Davis DR grading · NIDEK AFC-230 fundus camera — 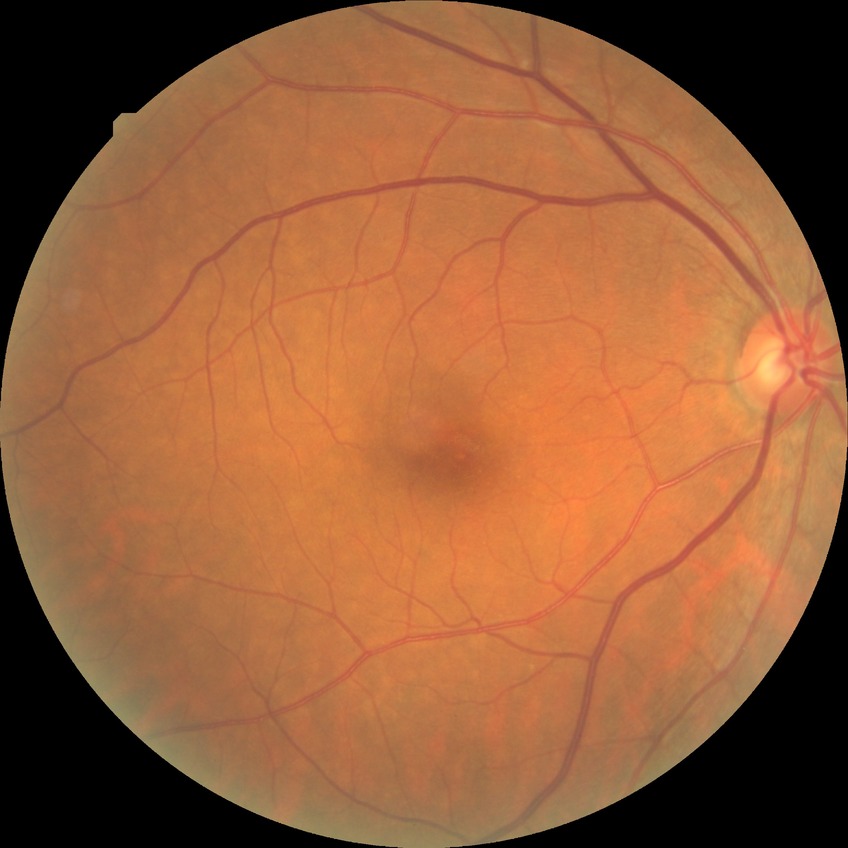
diabetic retinopathy (DR)=no diabetic retinopathy (NDR).